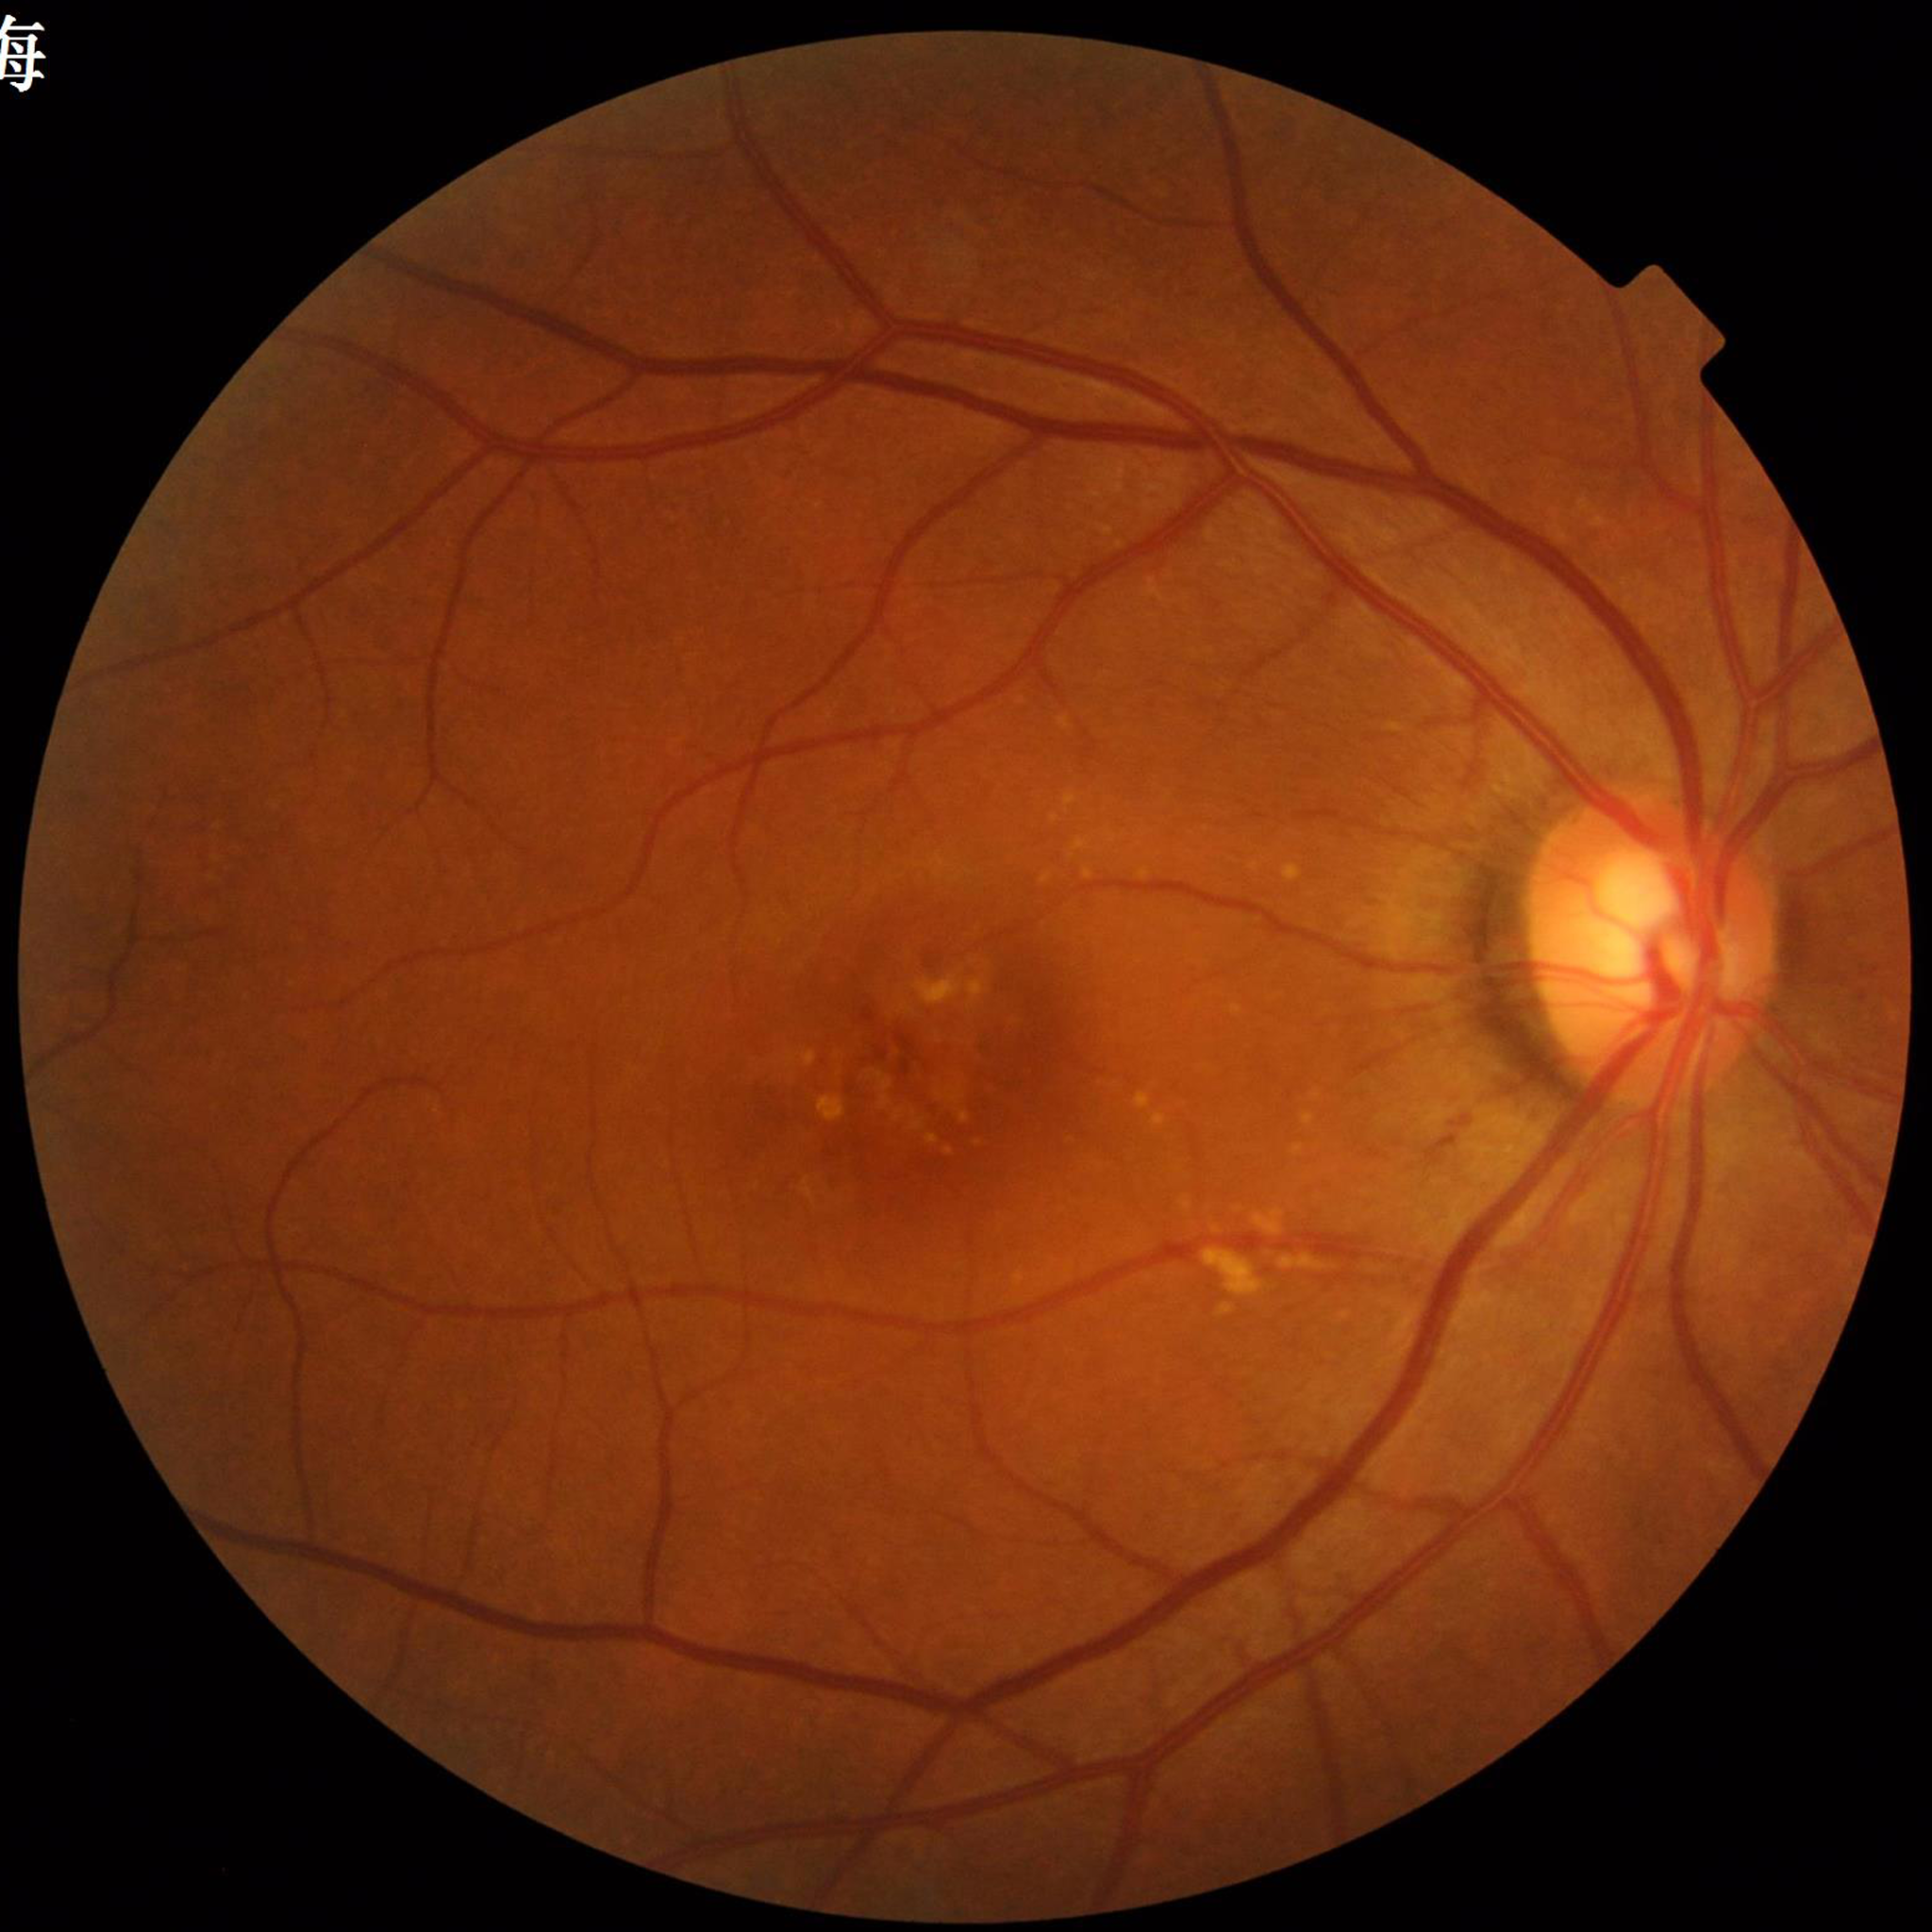 Automated quality assessment: good
Diagnosis: age-related macular degeneration